Color fundus photograph:
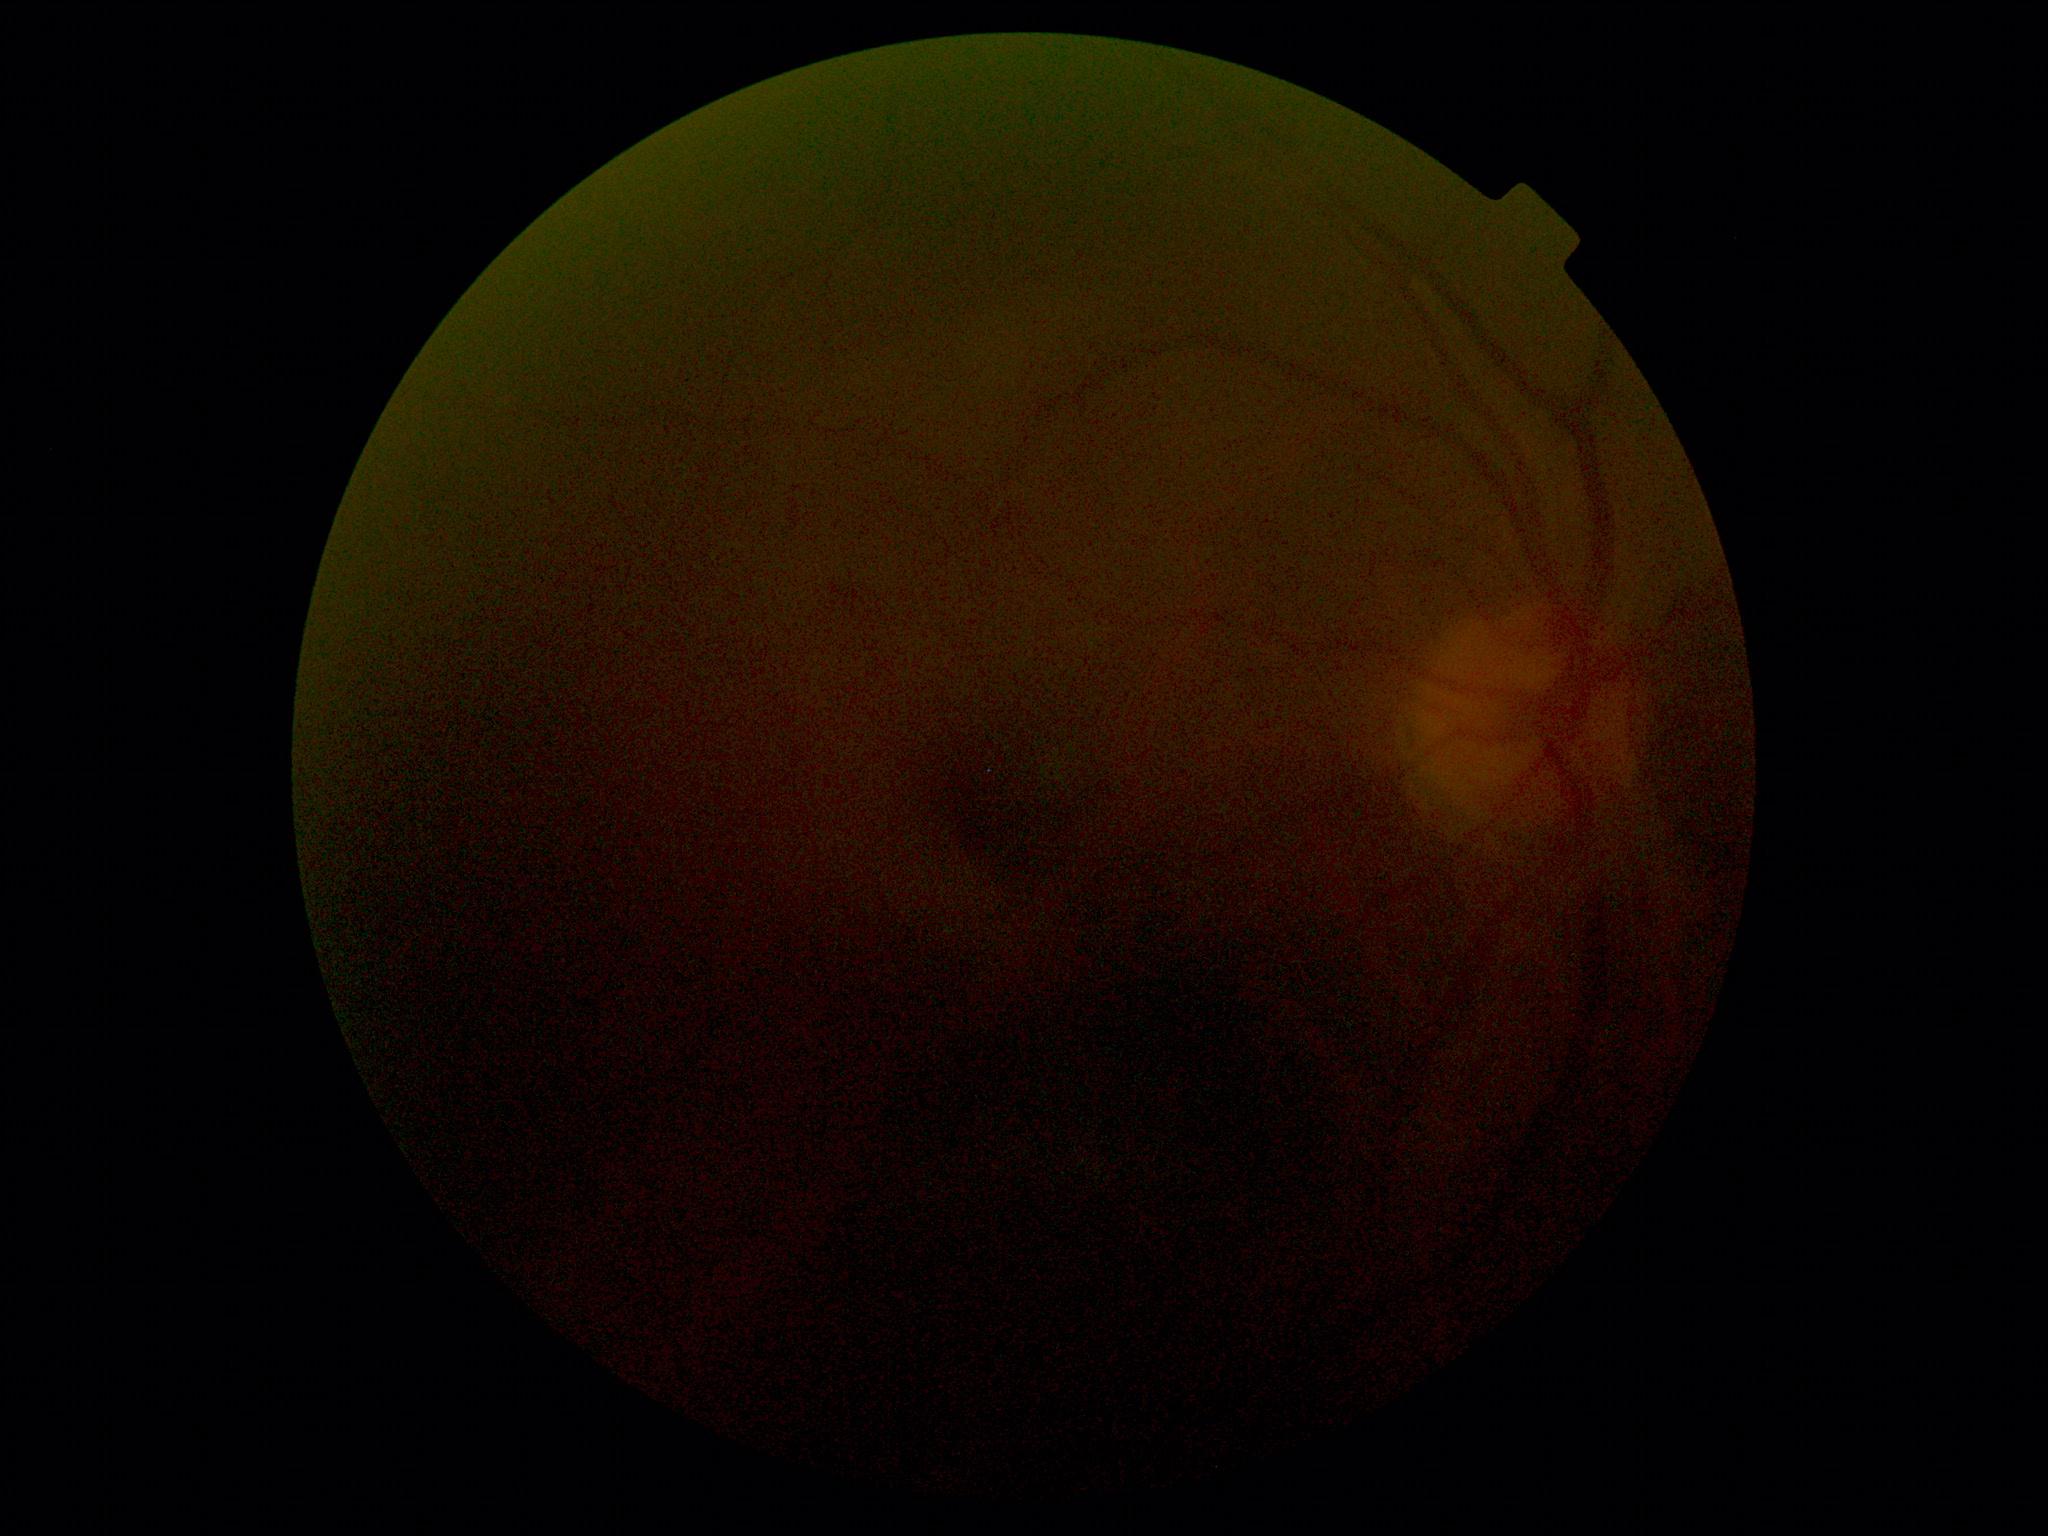 Findings:
– image quality — insufficient for DR assessment
– diabetic retinopathy severity — ungradable